2184x1690px — 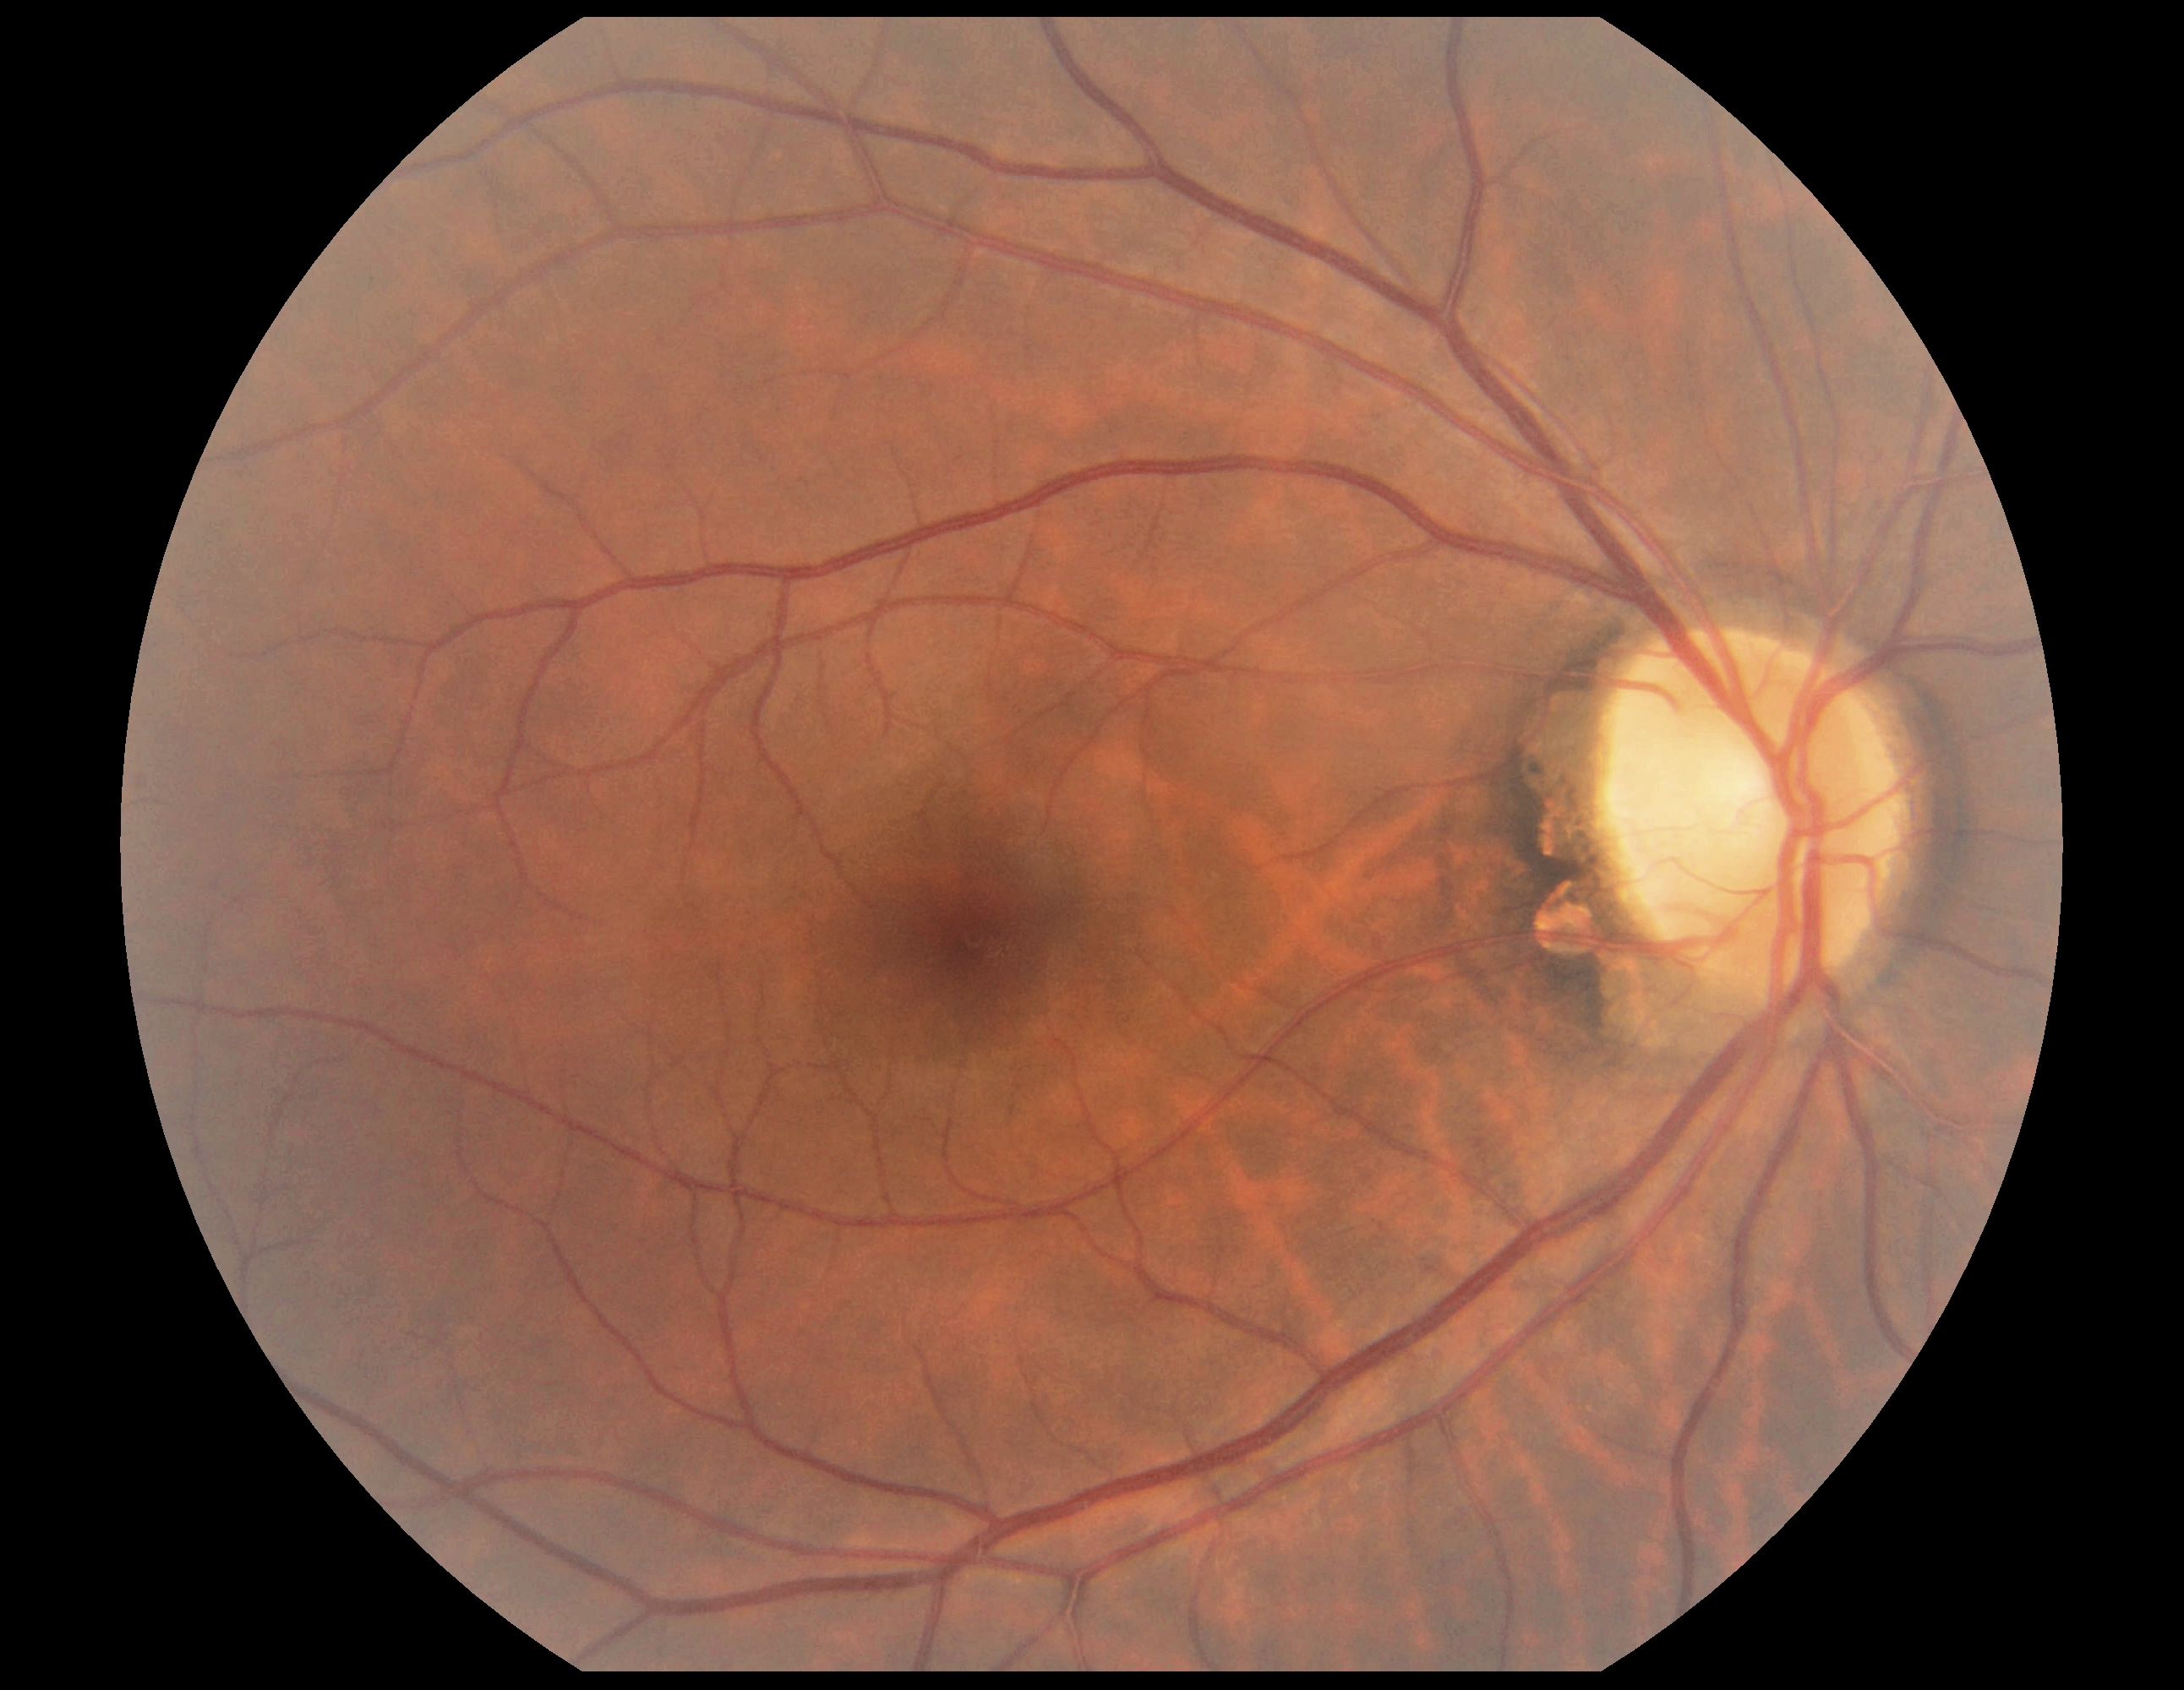
Diabetic retinopathy severity: no apparent diabetic retinopathy (grade 0).